2212 by 1659 pixels: 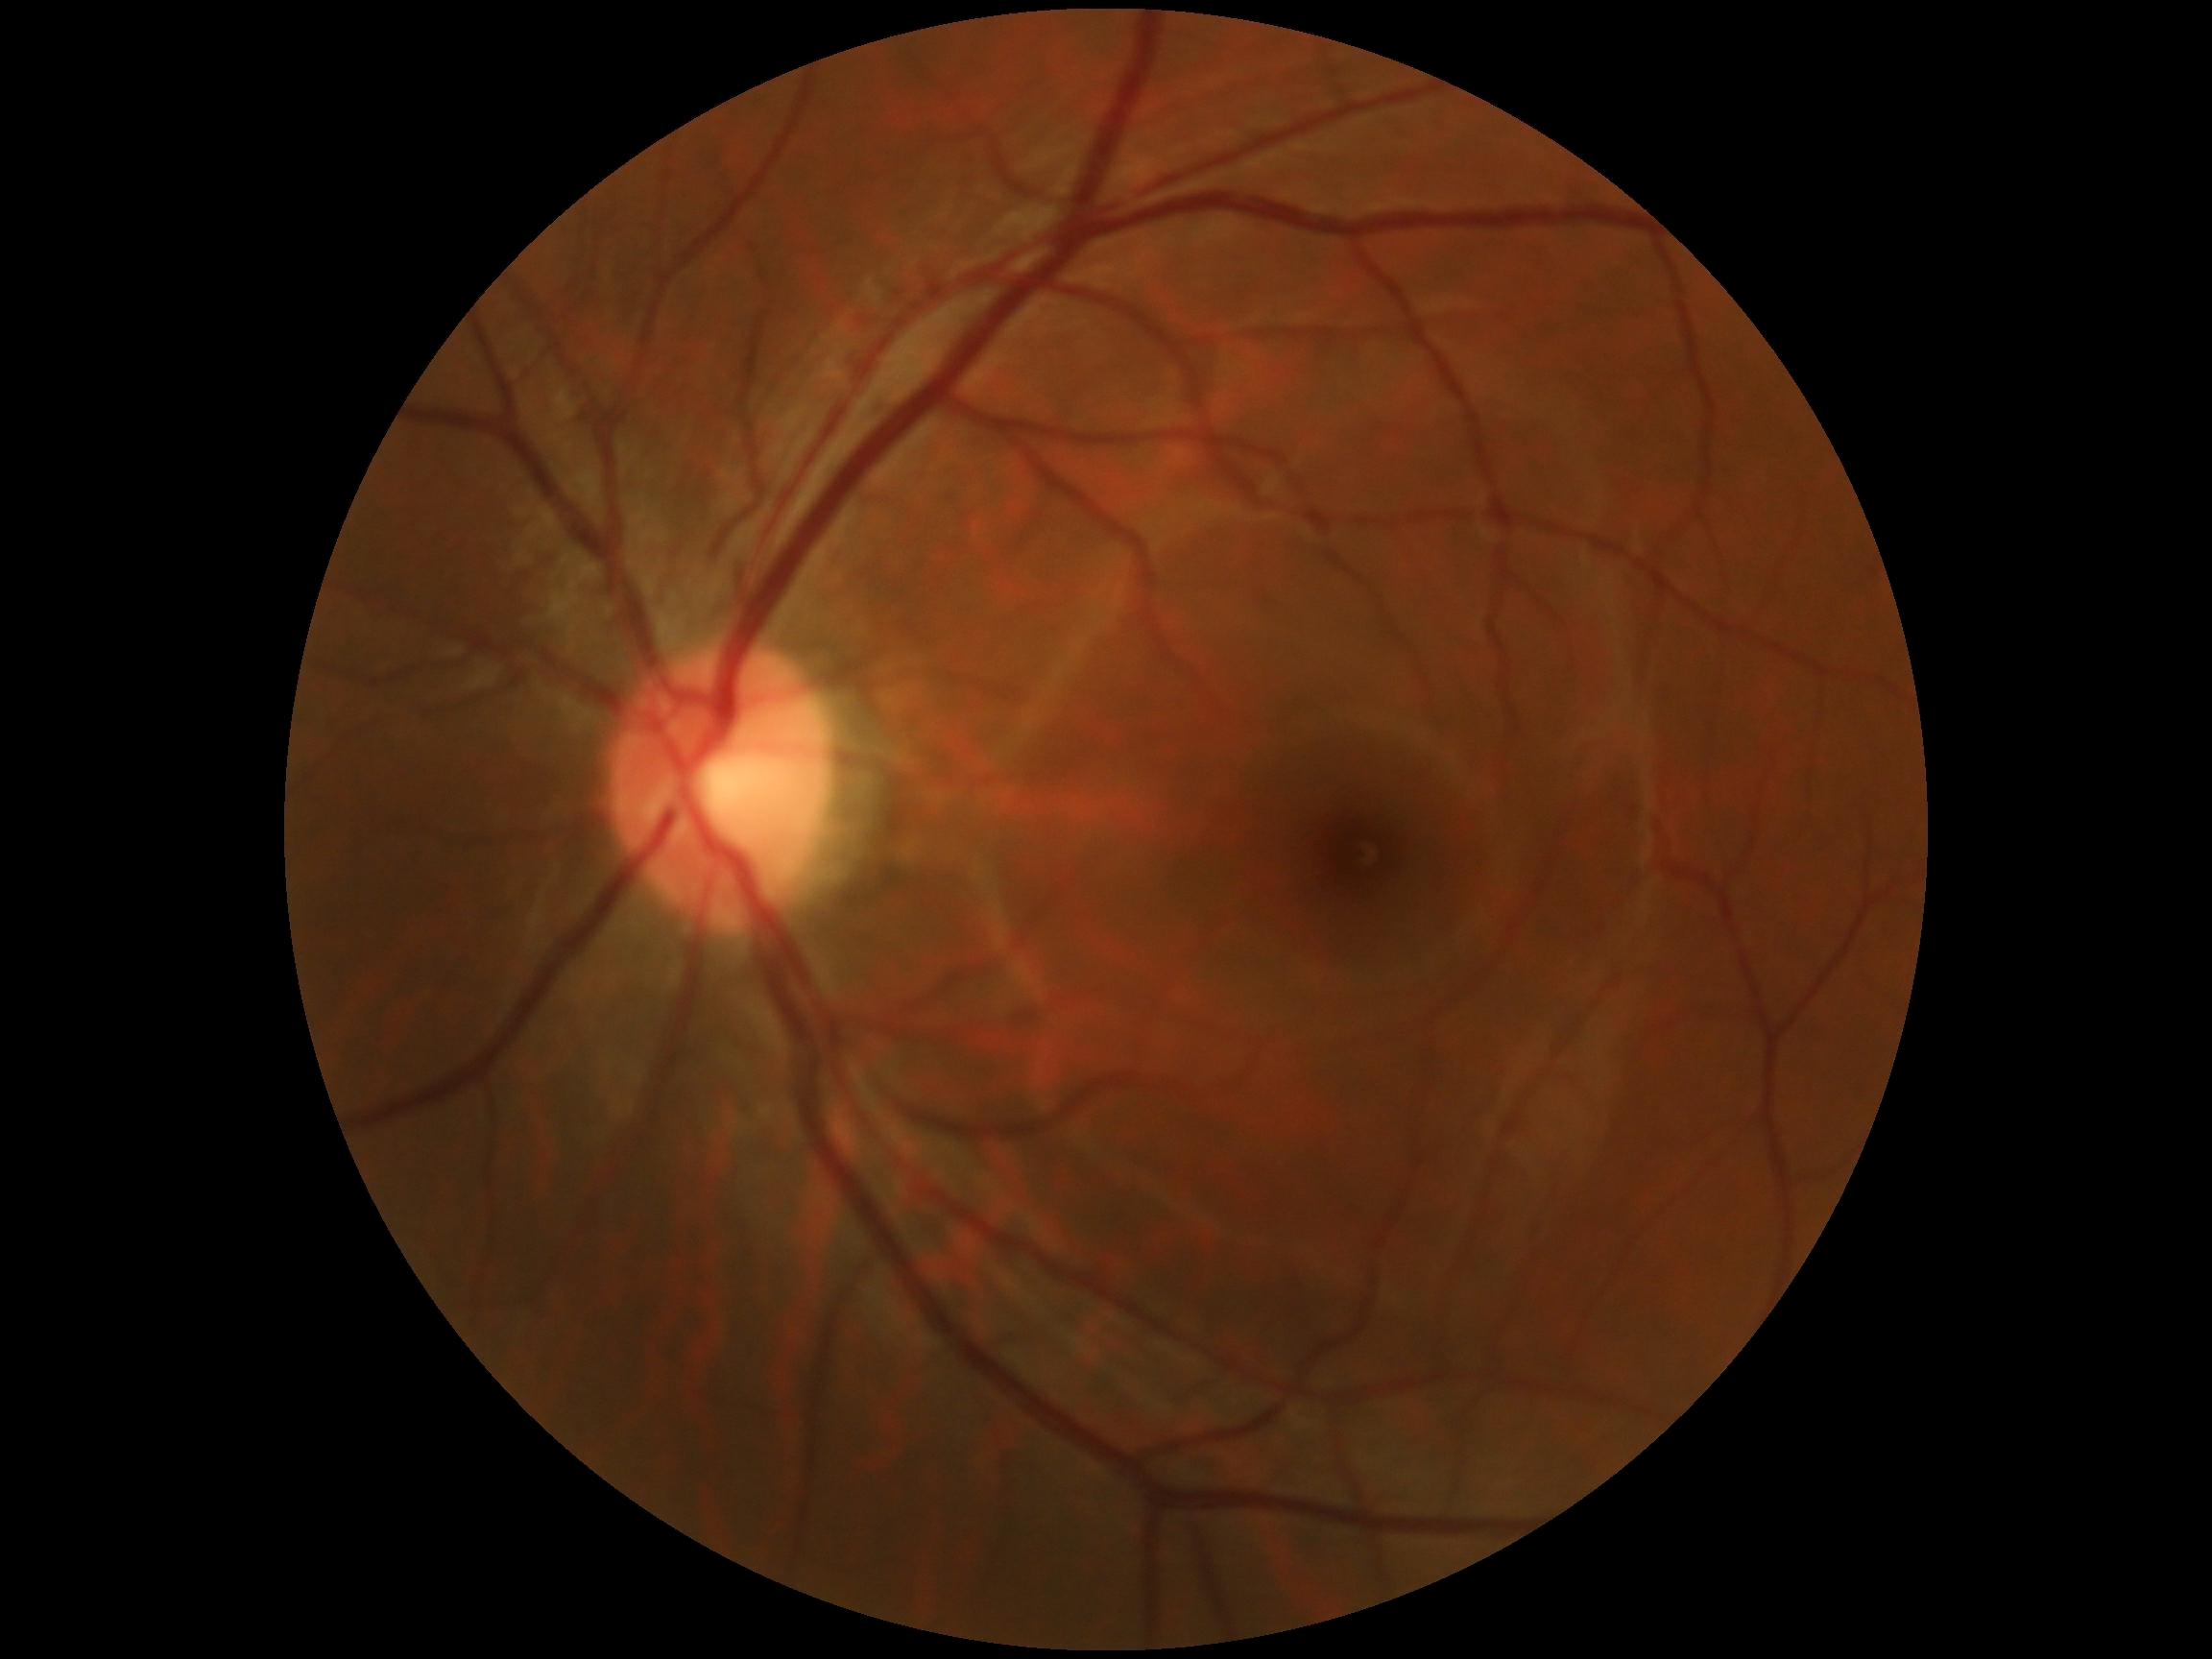

DR impression: negative for DR, retinopathy grade: no apparent retinopathy (0).